2352 by 1568 pixels, fundus photo.
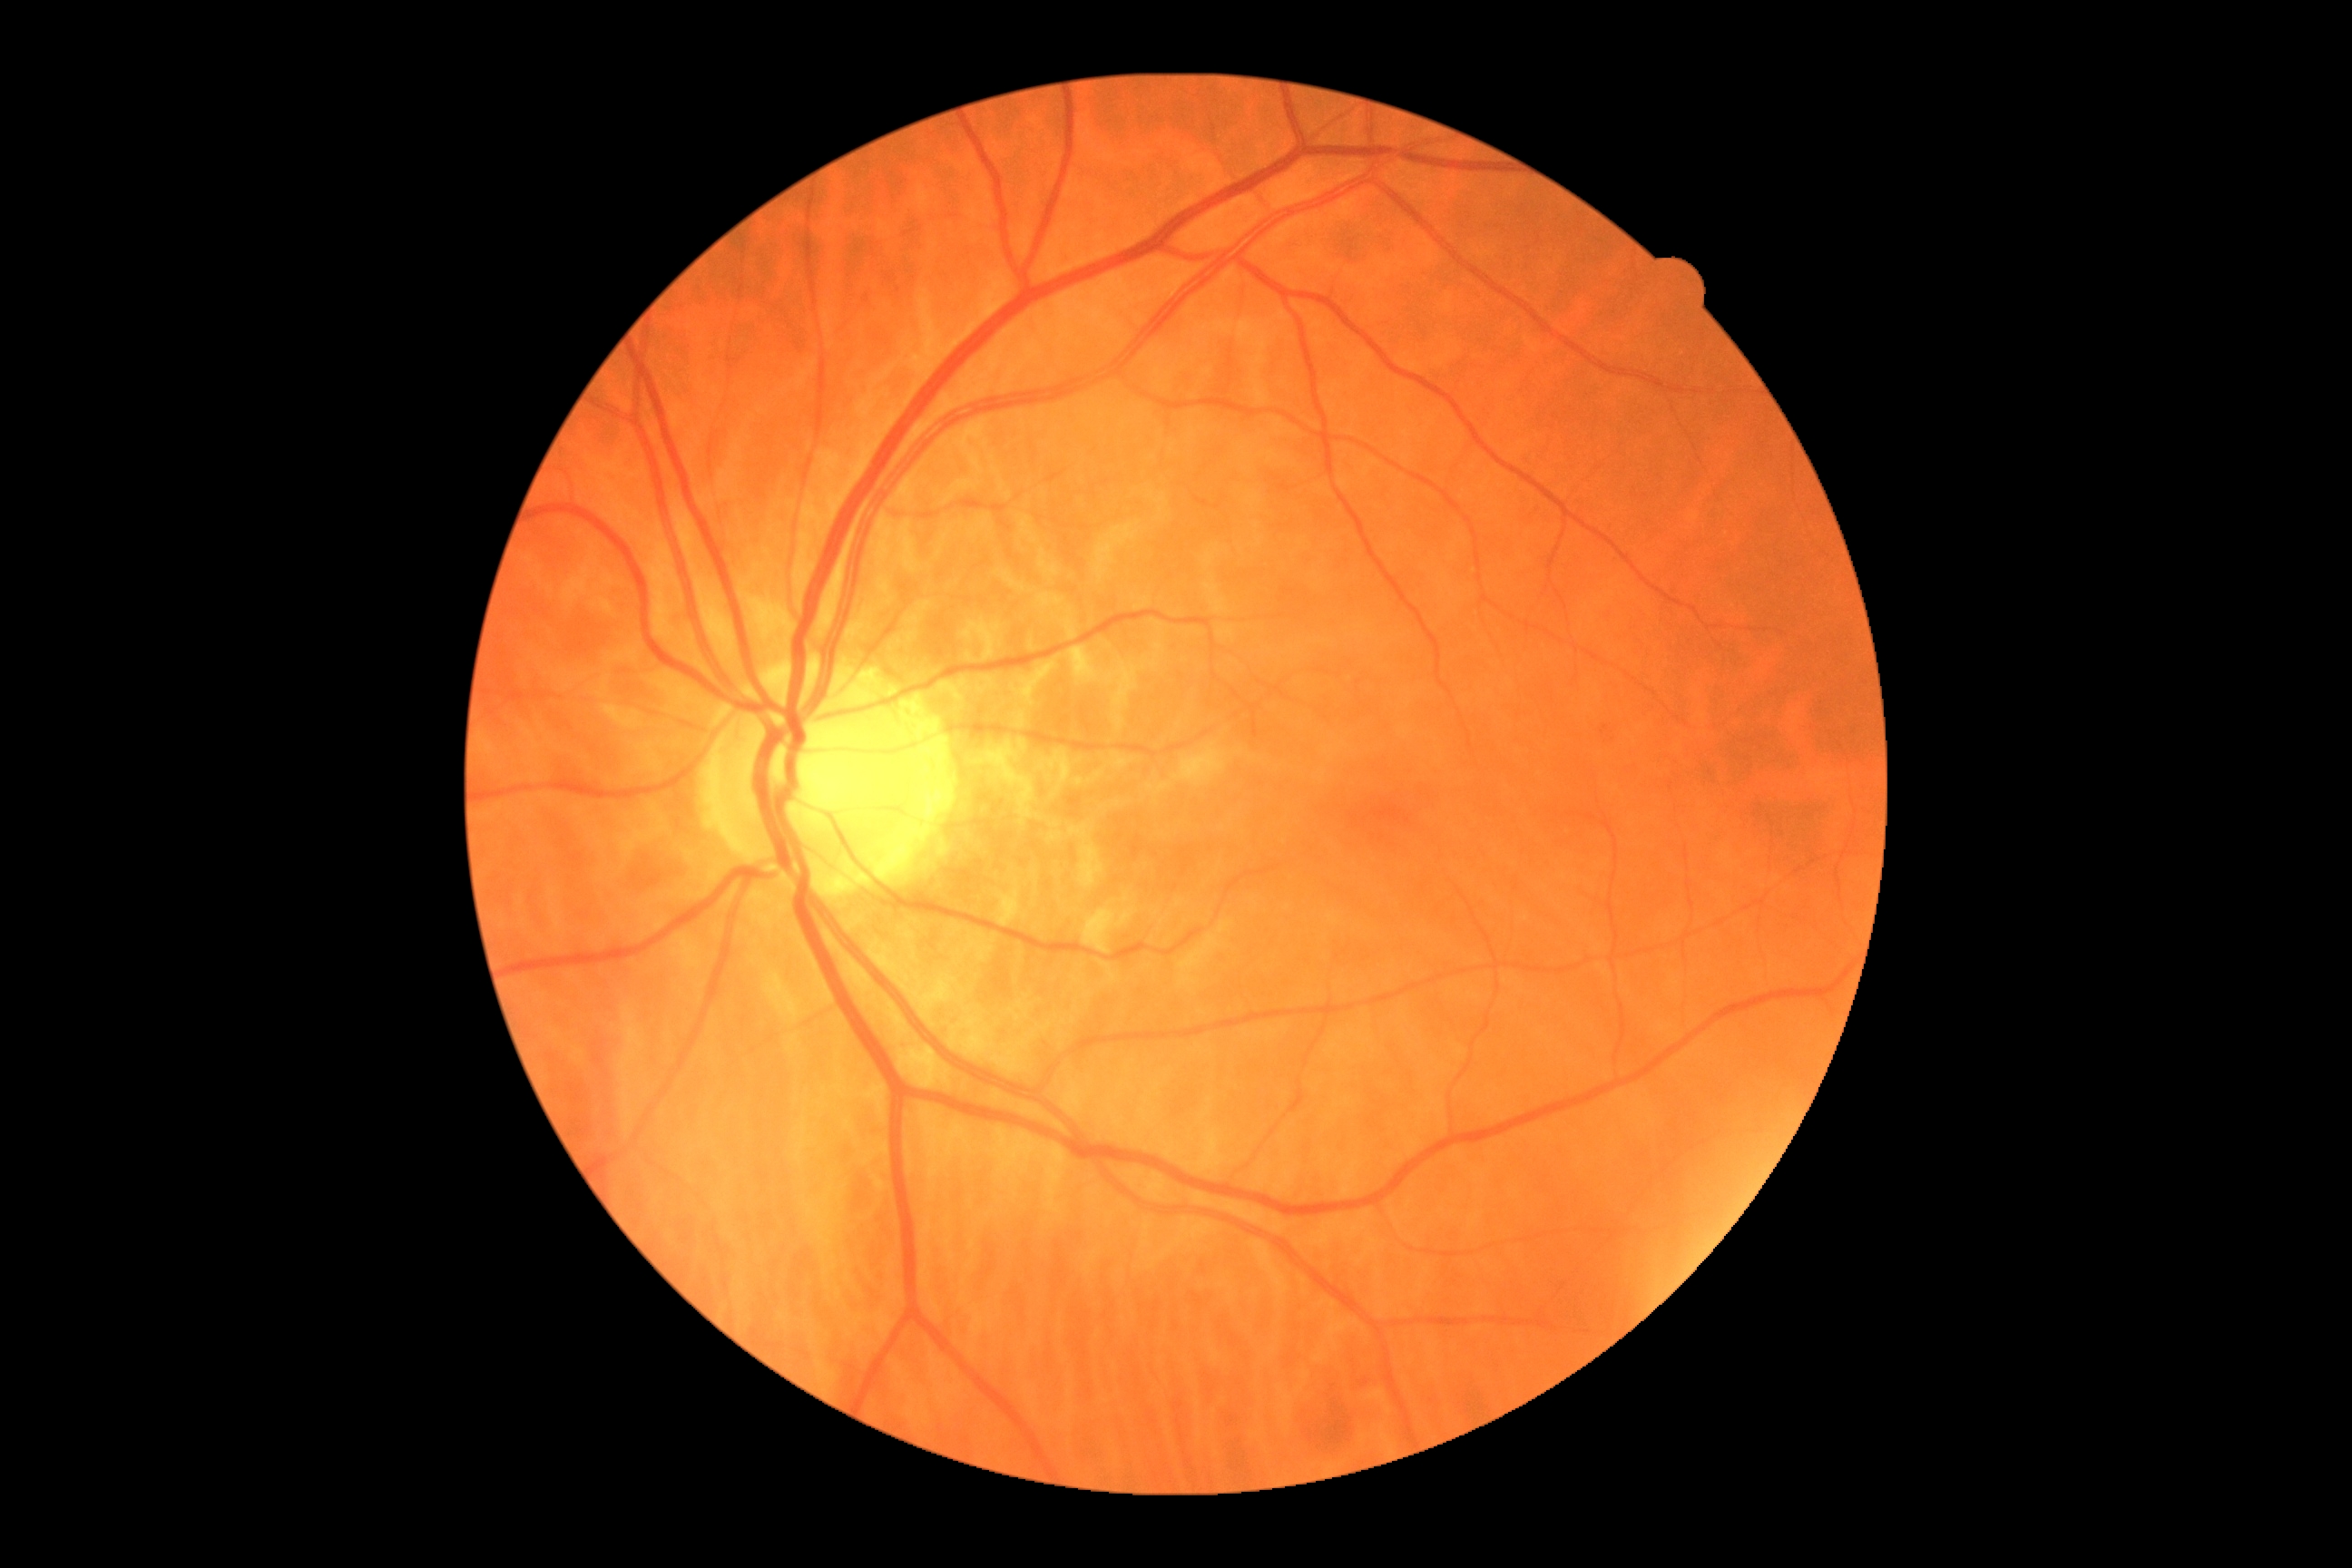

{"dr_grade": "grade 0", "dr_impression": "no apparent DR"}